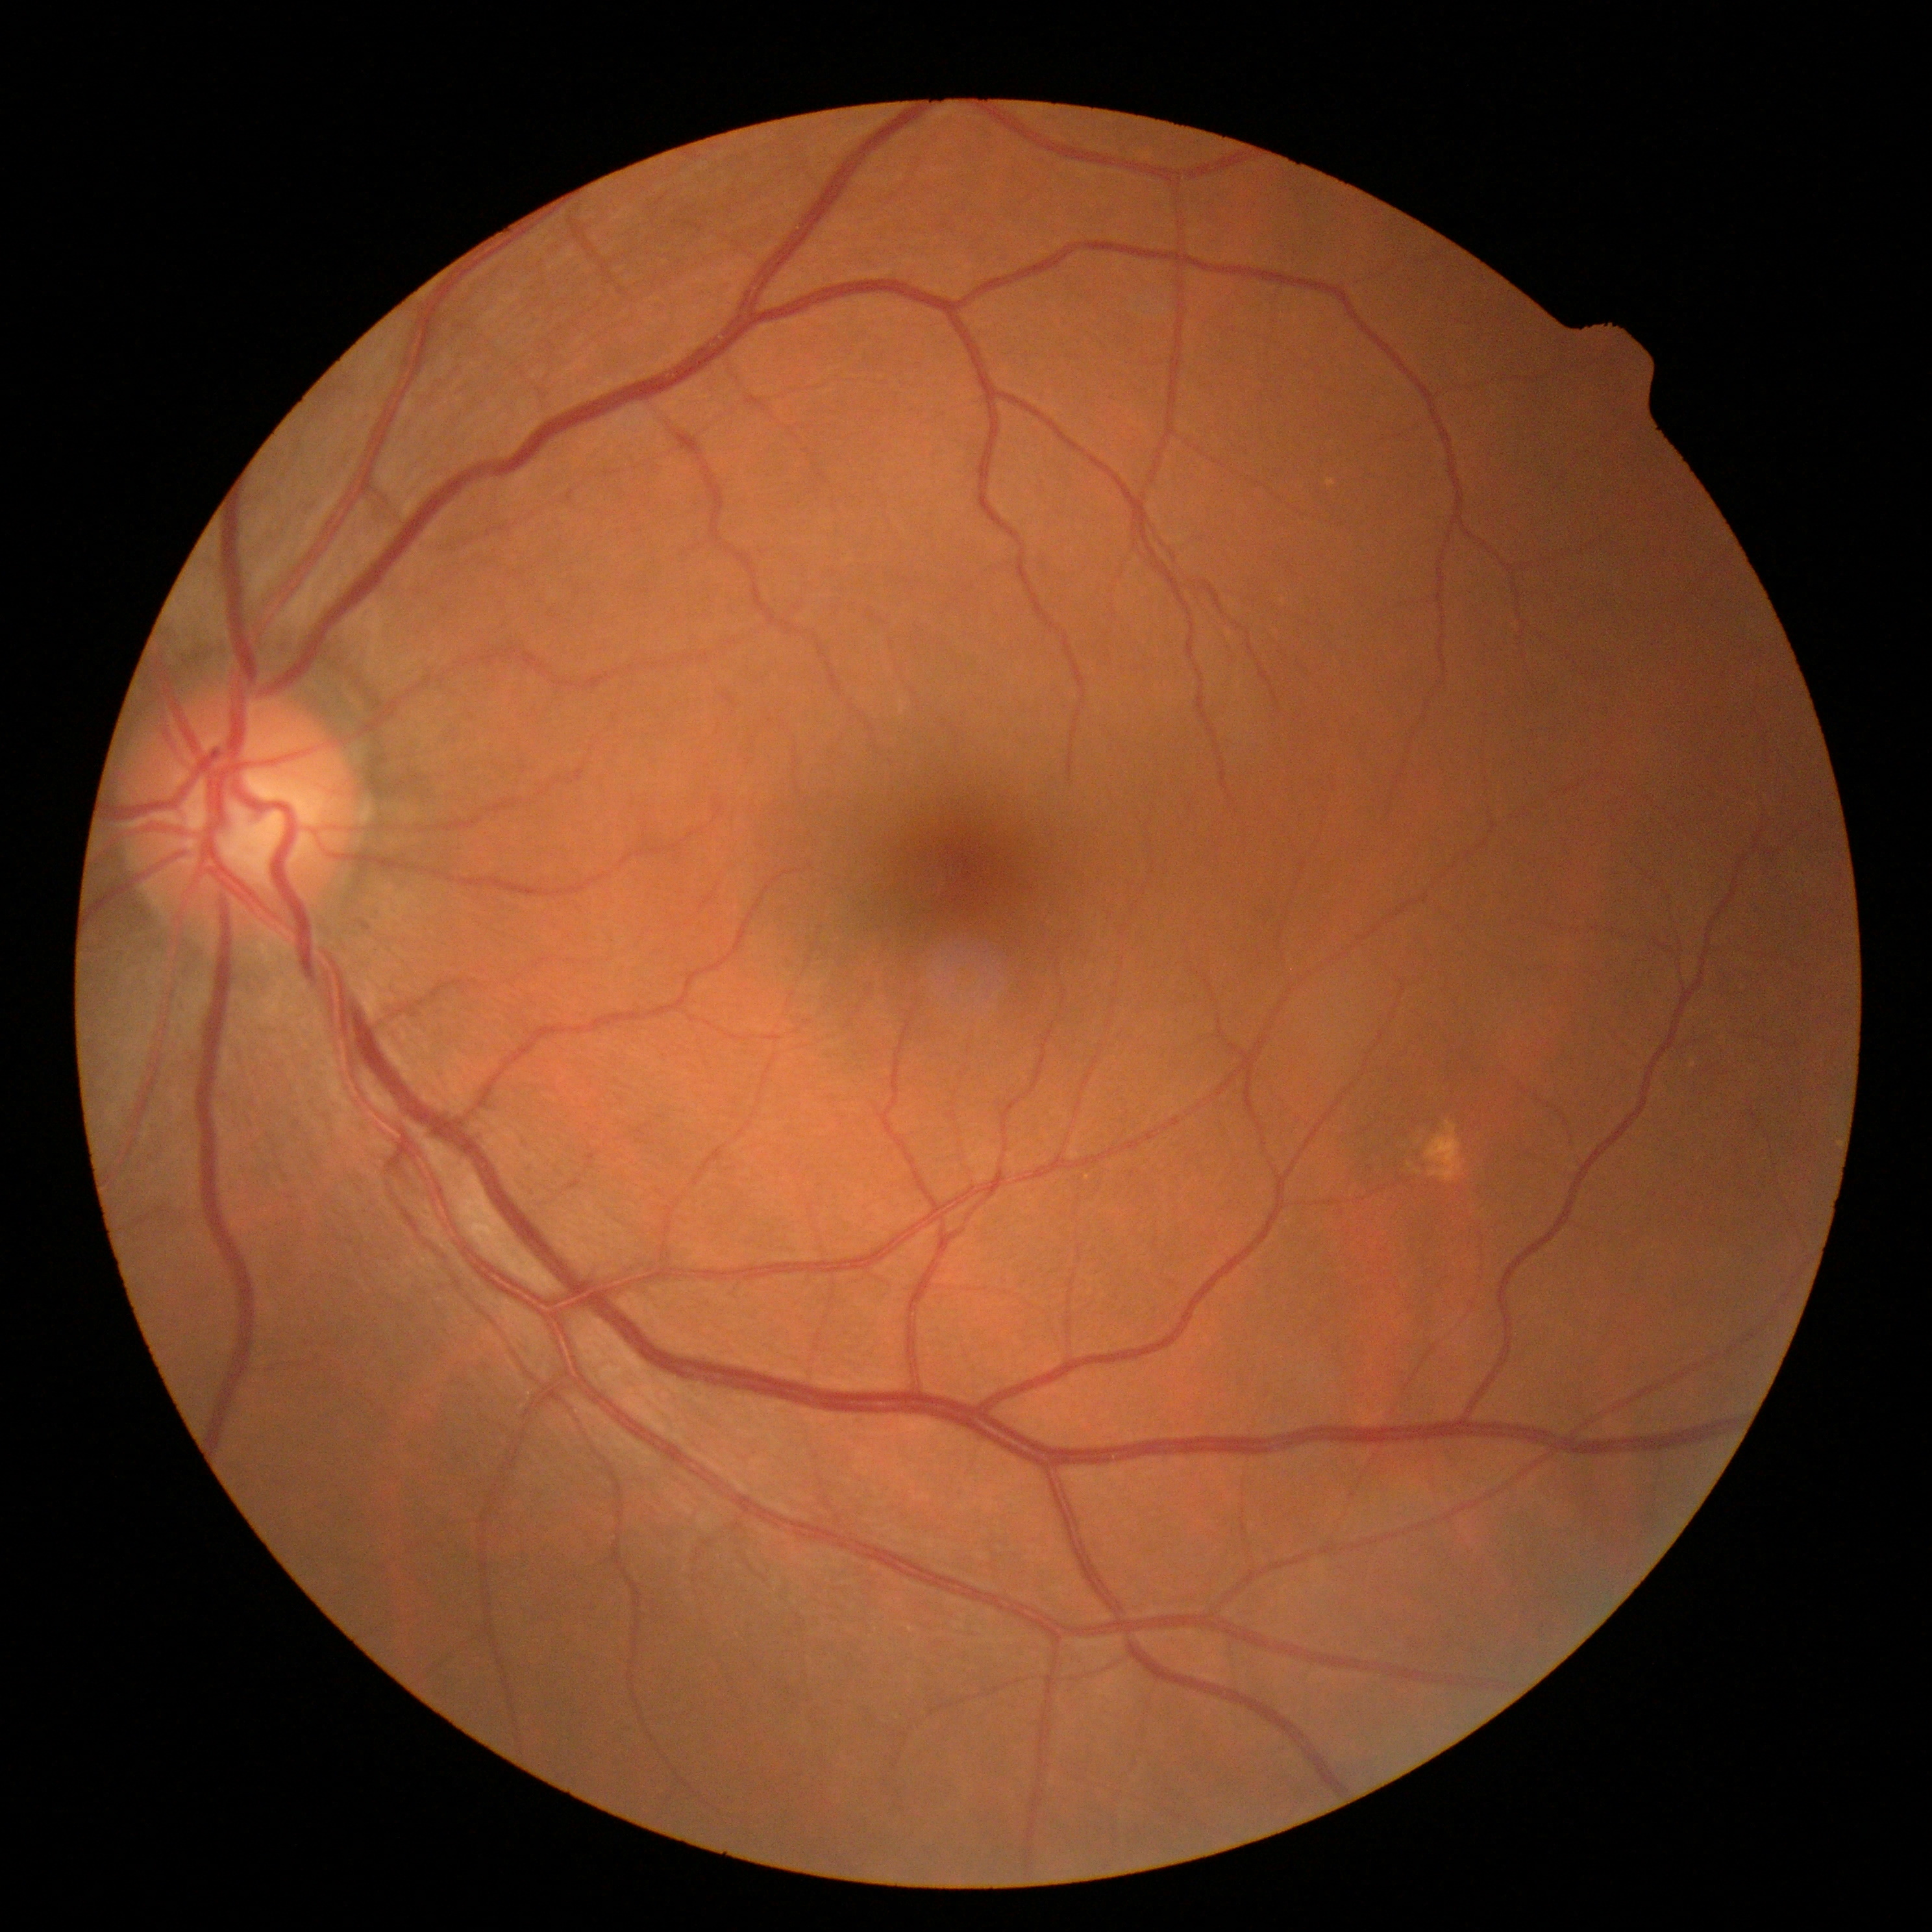
{
  "dr_grade": "0/4"
}